Nonmydriatic fundus photograph. NIDEK AFC-230 fundus camera
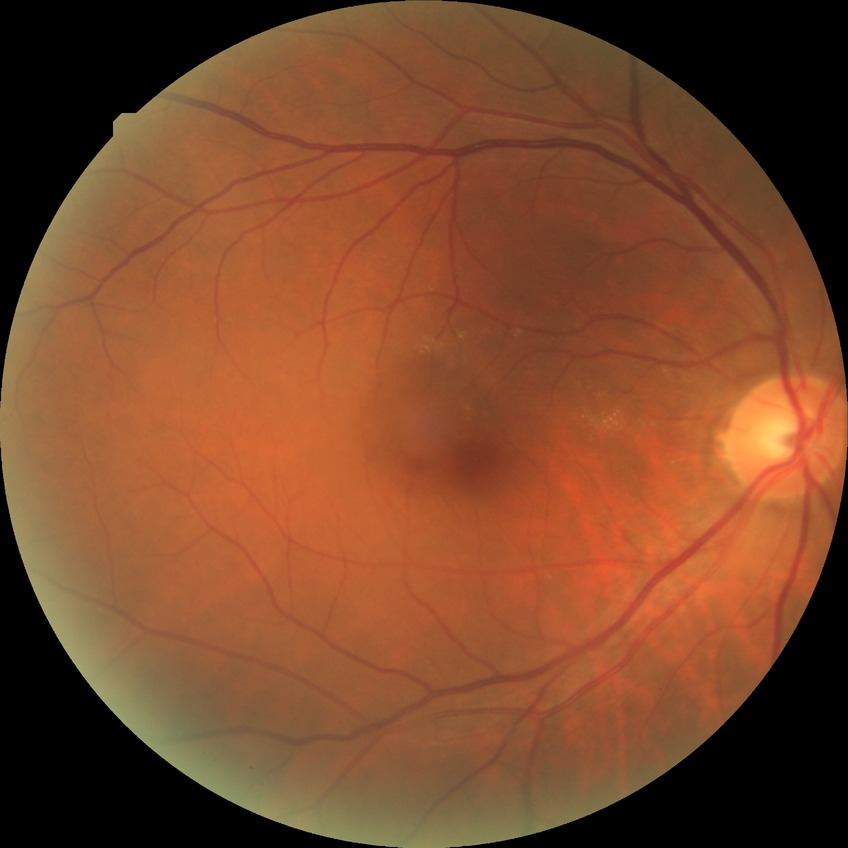 diabetic retinopathy severity: no diabetic retinopathy.